Wide-field fundus photograph of an infant · camera: Clarity RetCam 3 (130° FOV) · 640x480px
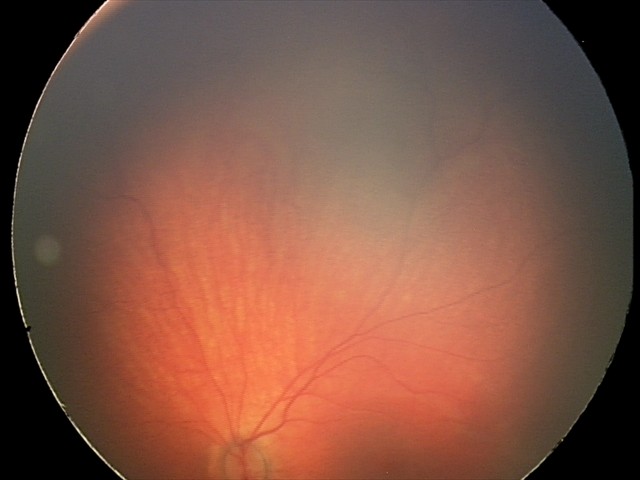 Diagnosis = retinal hemorrhages.